Wide-field contact fundus photograph of an infant — 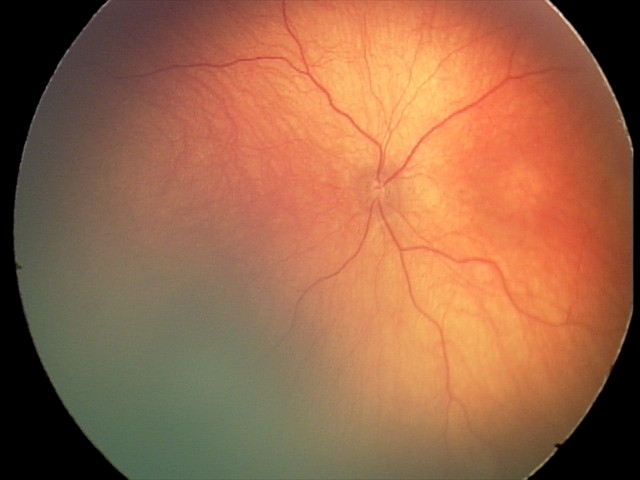
Screening series with optic nerve hypoplasia.